45° field of view. CFP — 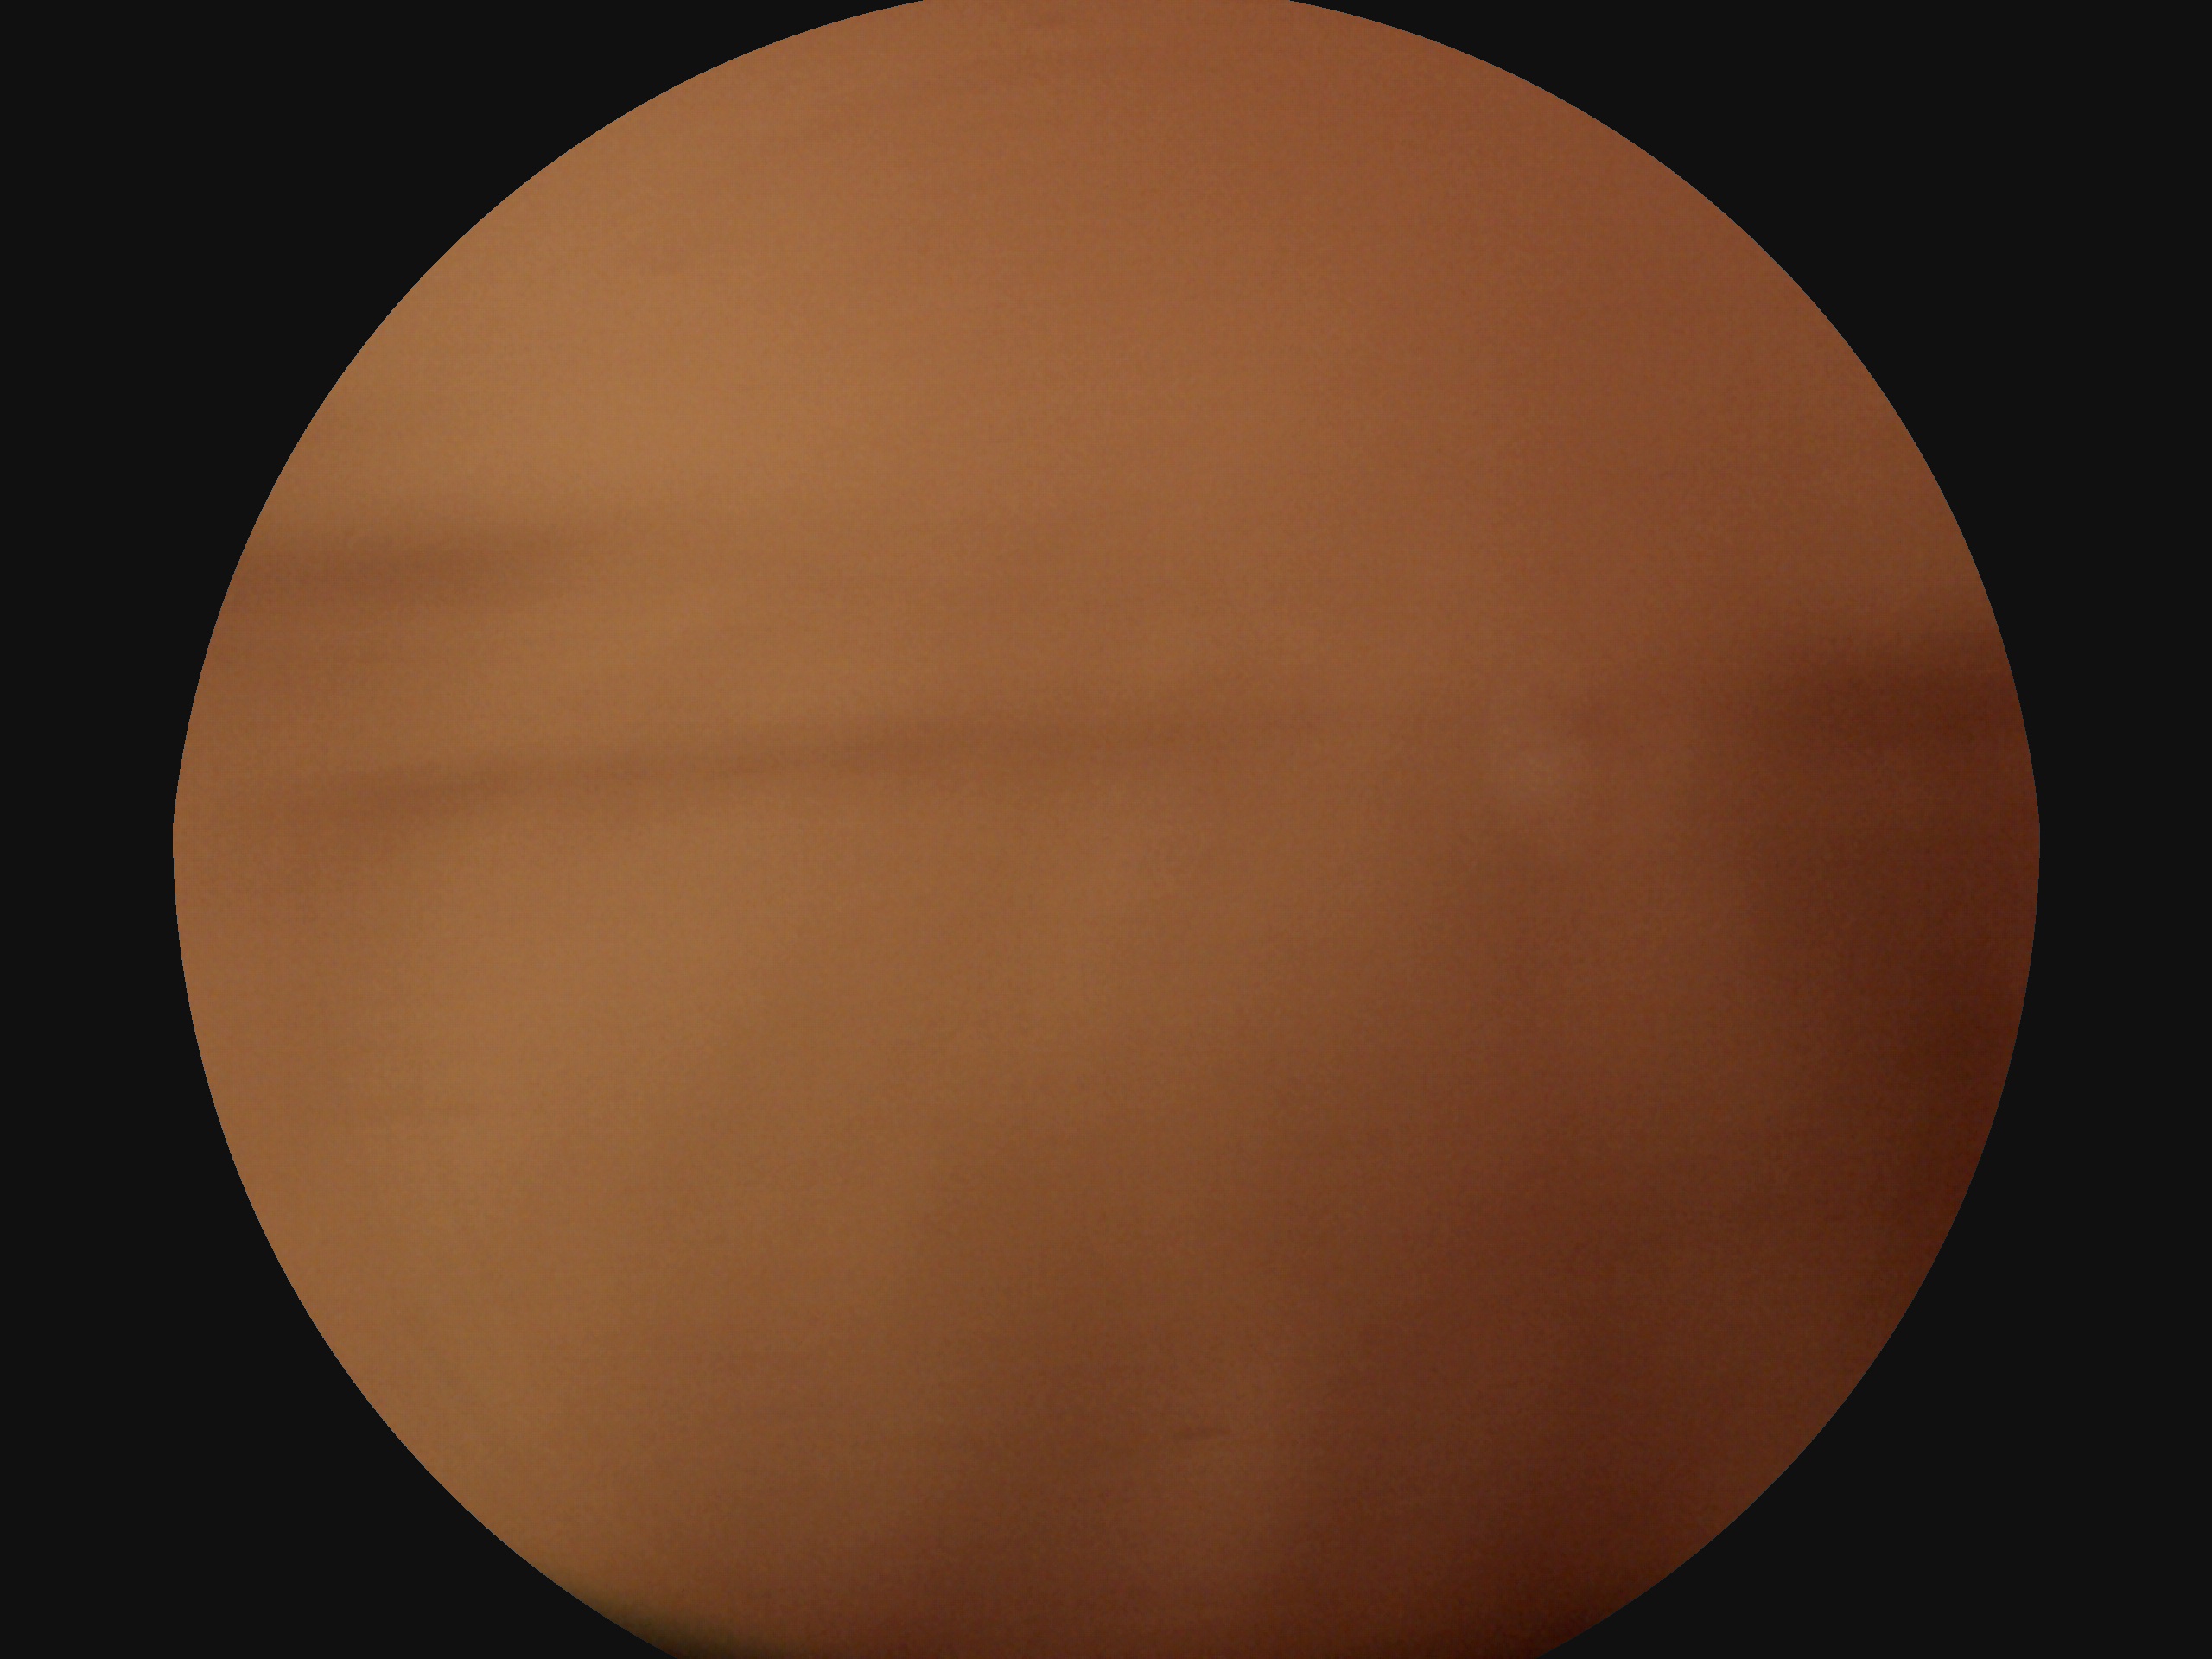

DR stage: ungradable.